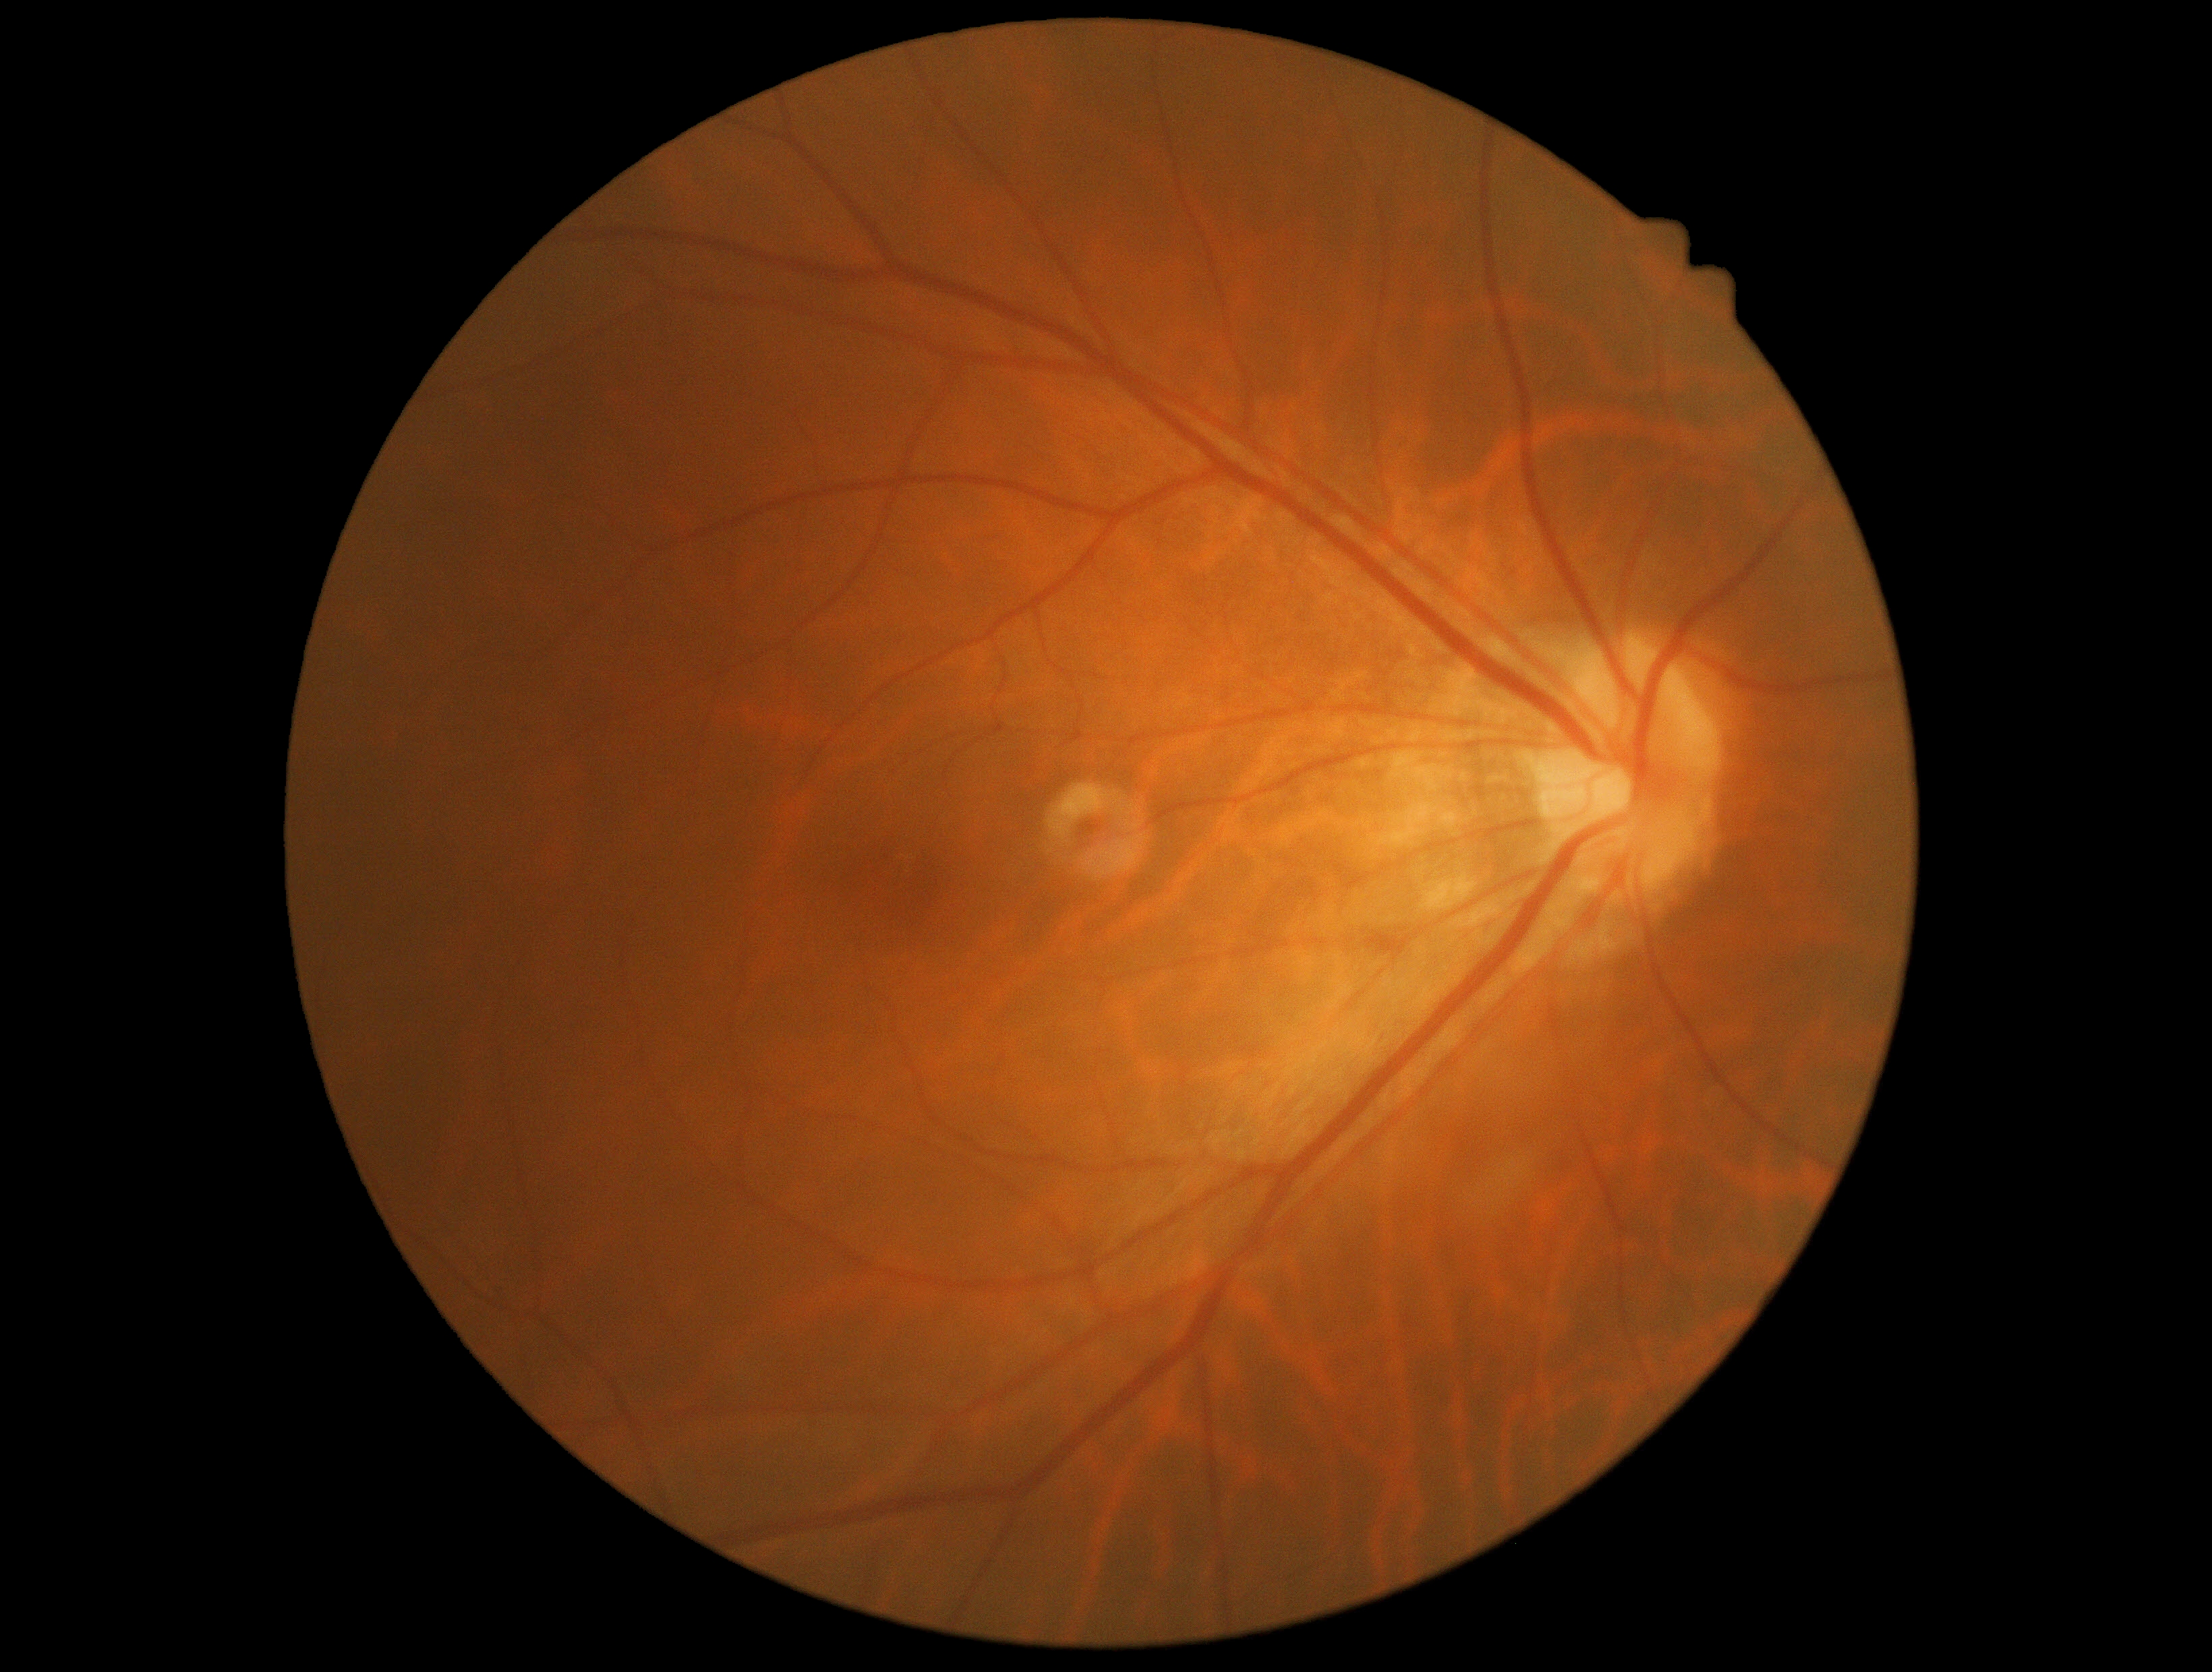 diabetic retinopathy (DR)=0/4, DR impression=no DR findings.